Color fundus photograph from a handheld portable camera. 60° field of view
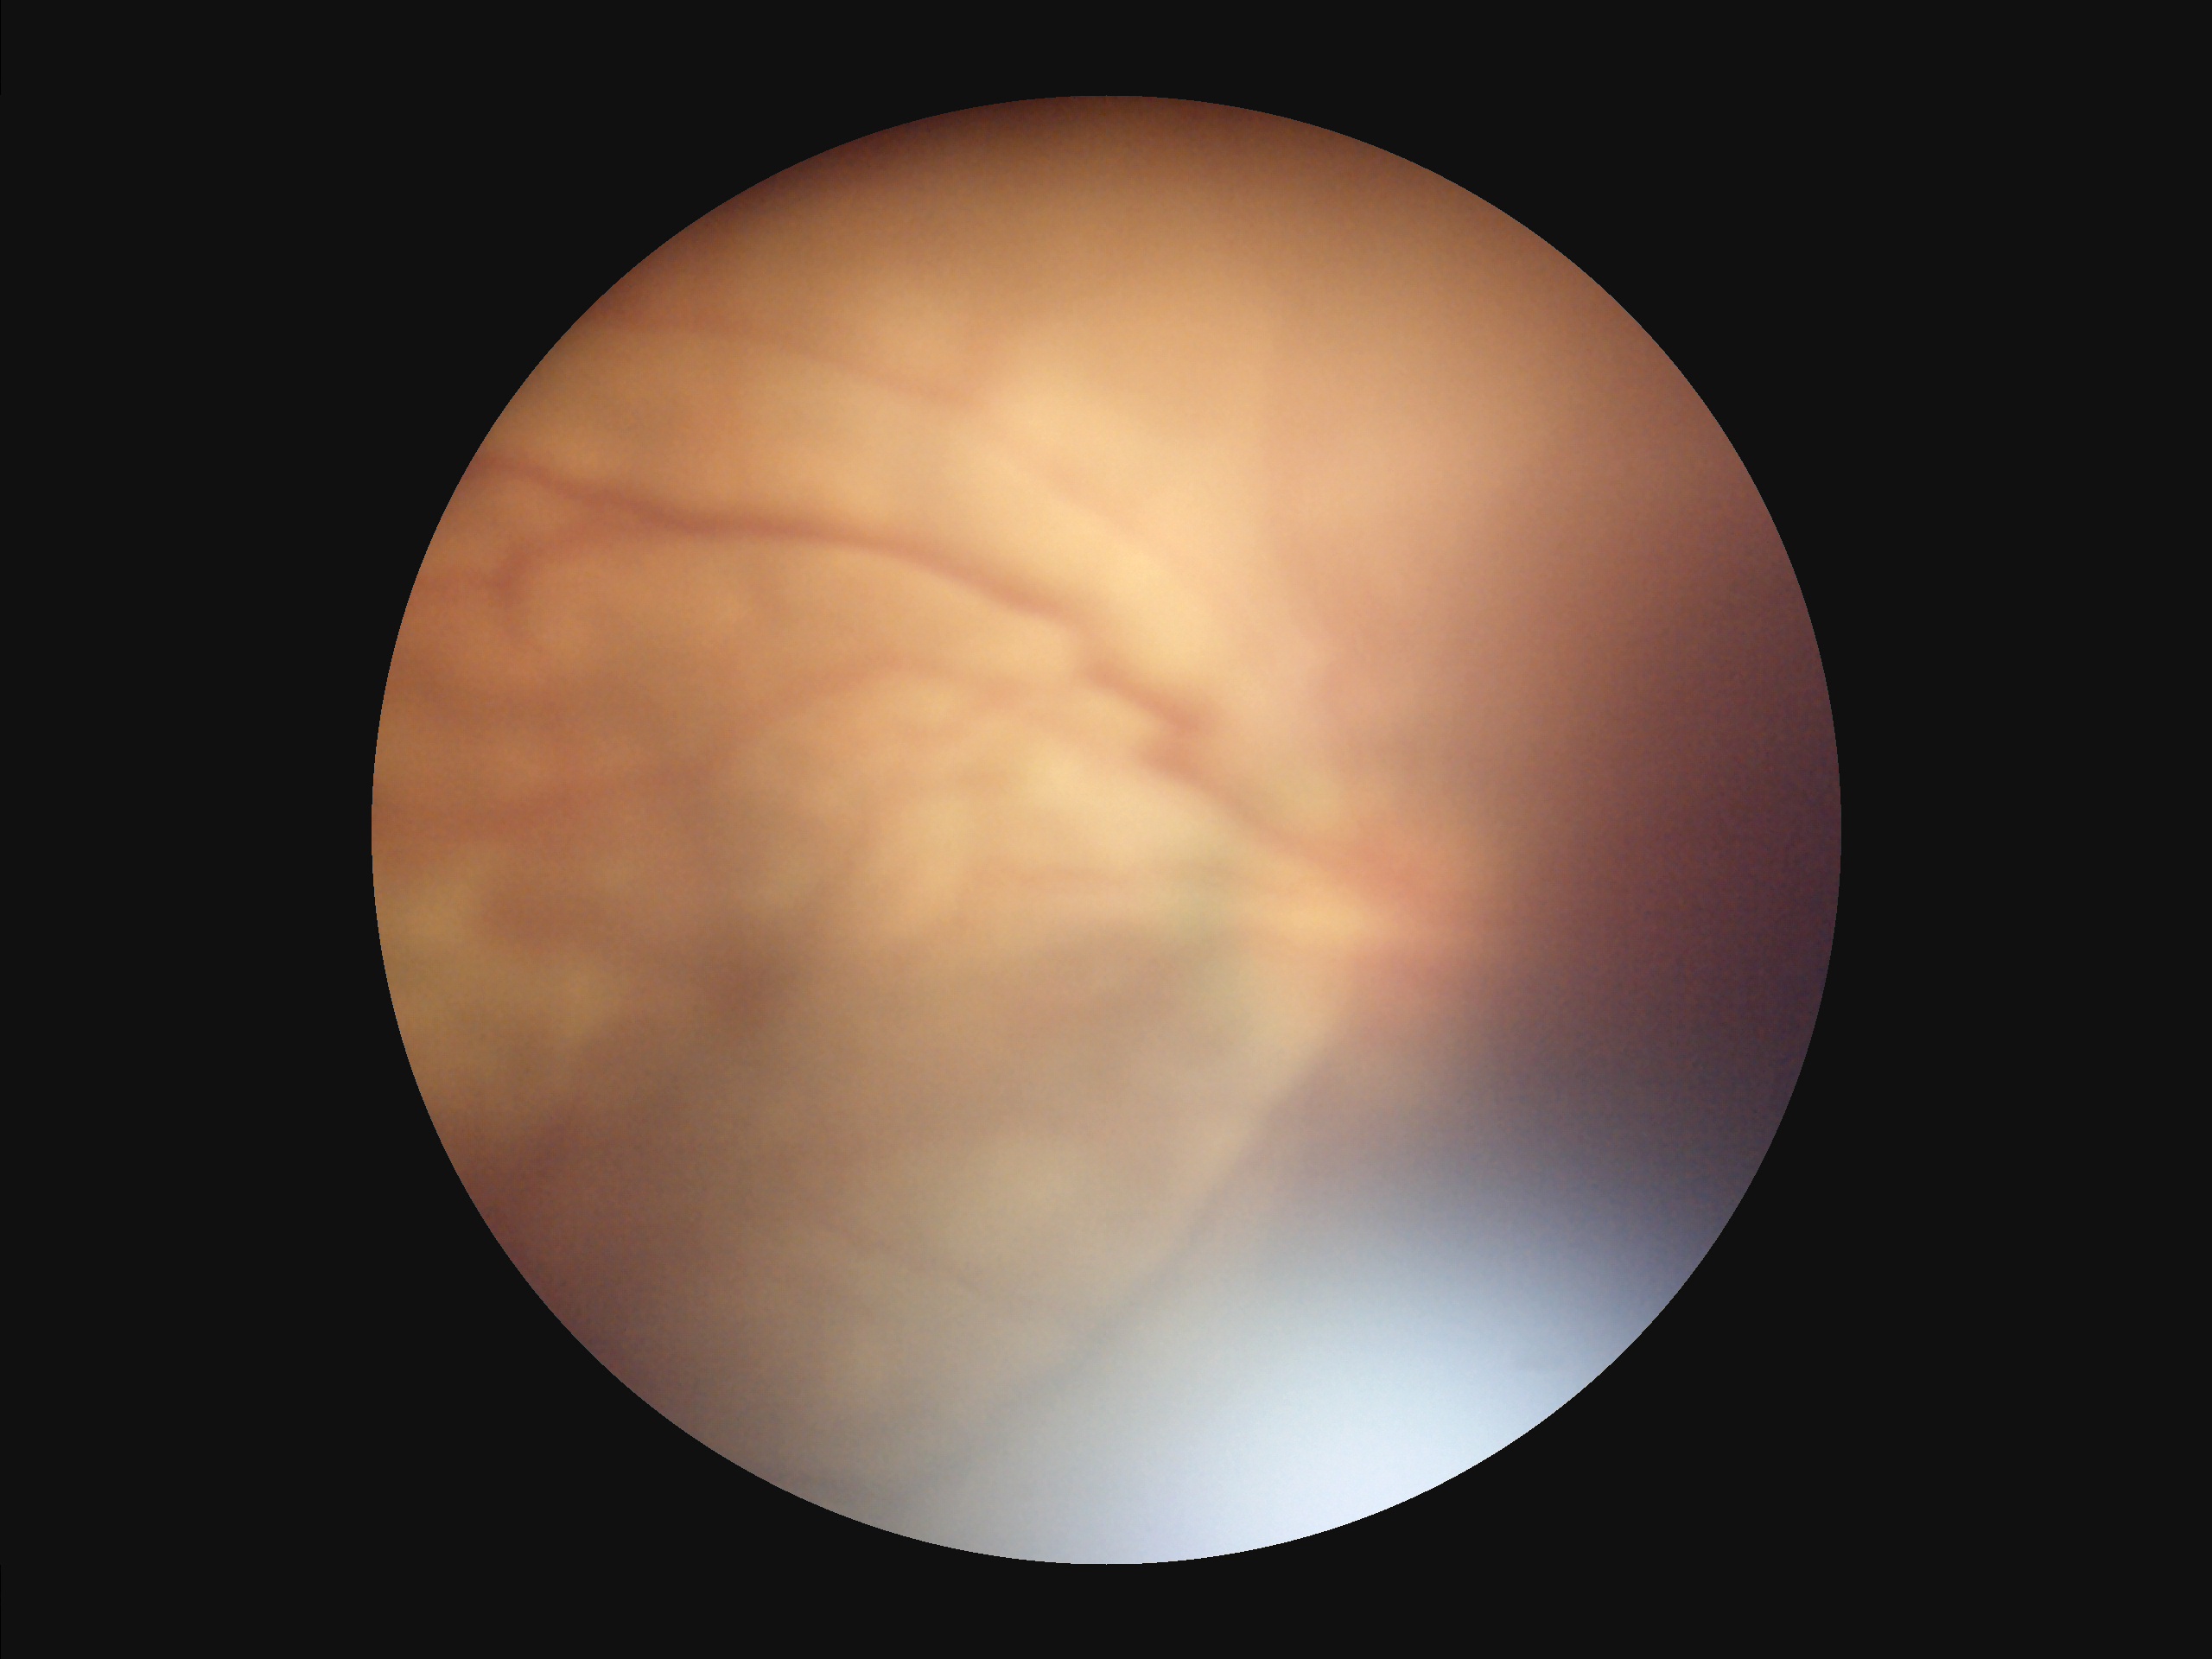

Quality assessment: illumination: uneven; sharpness: reduced; overall: inadequate; contrast: low.